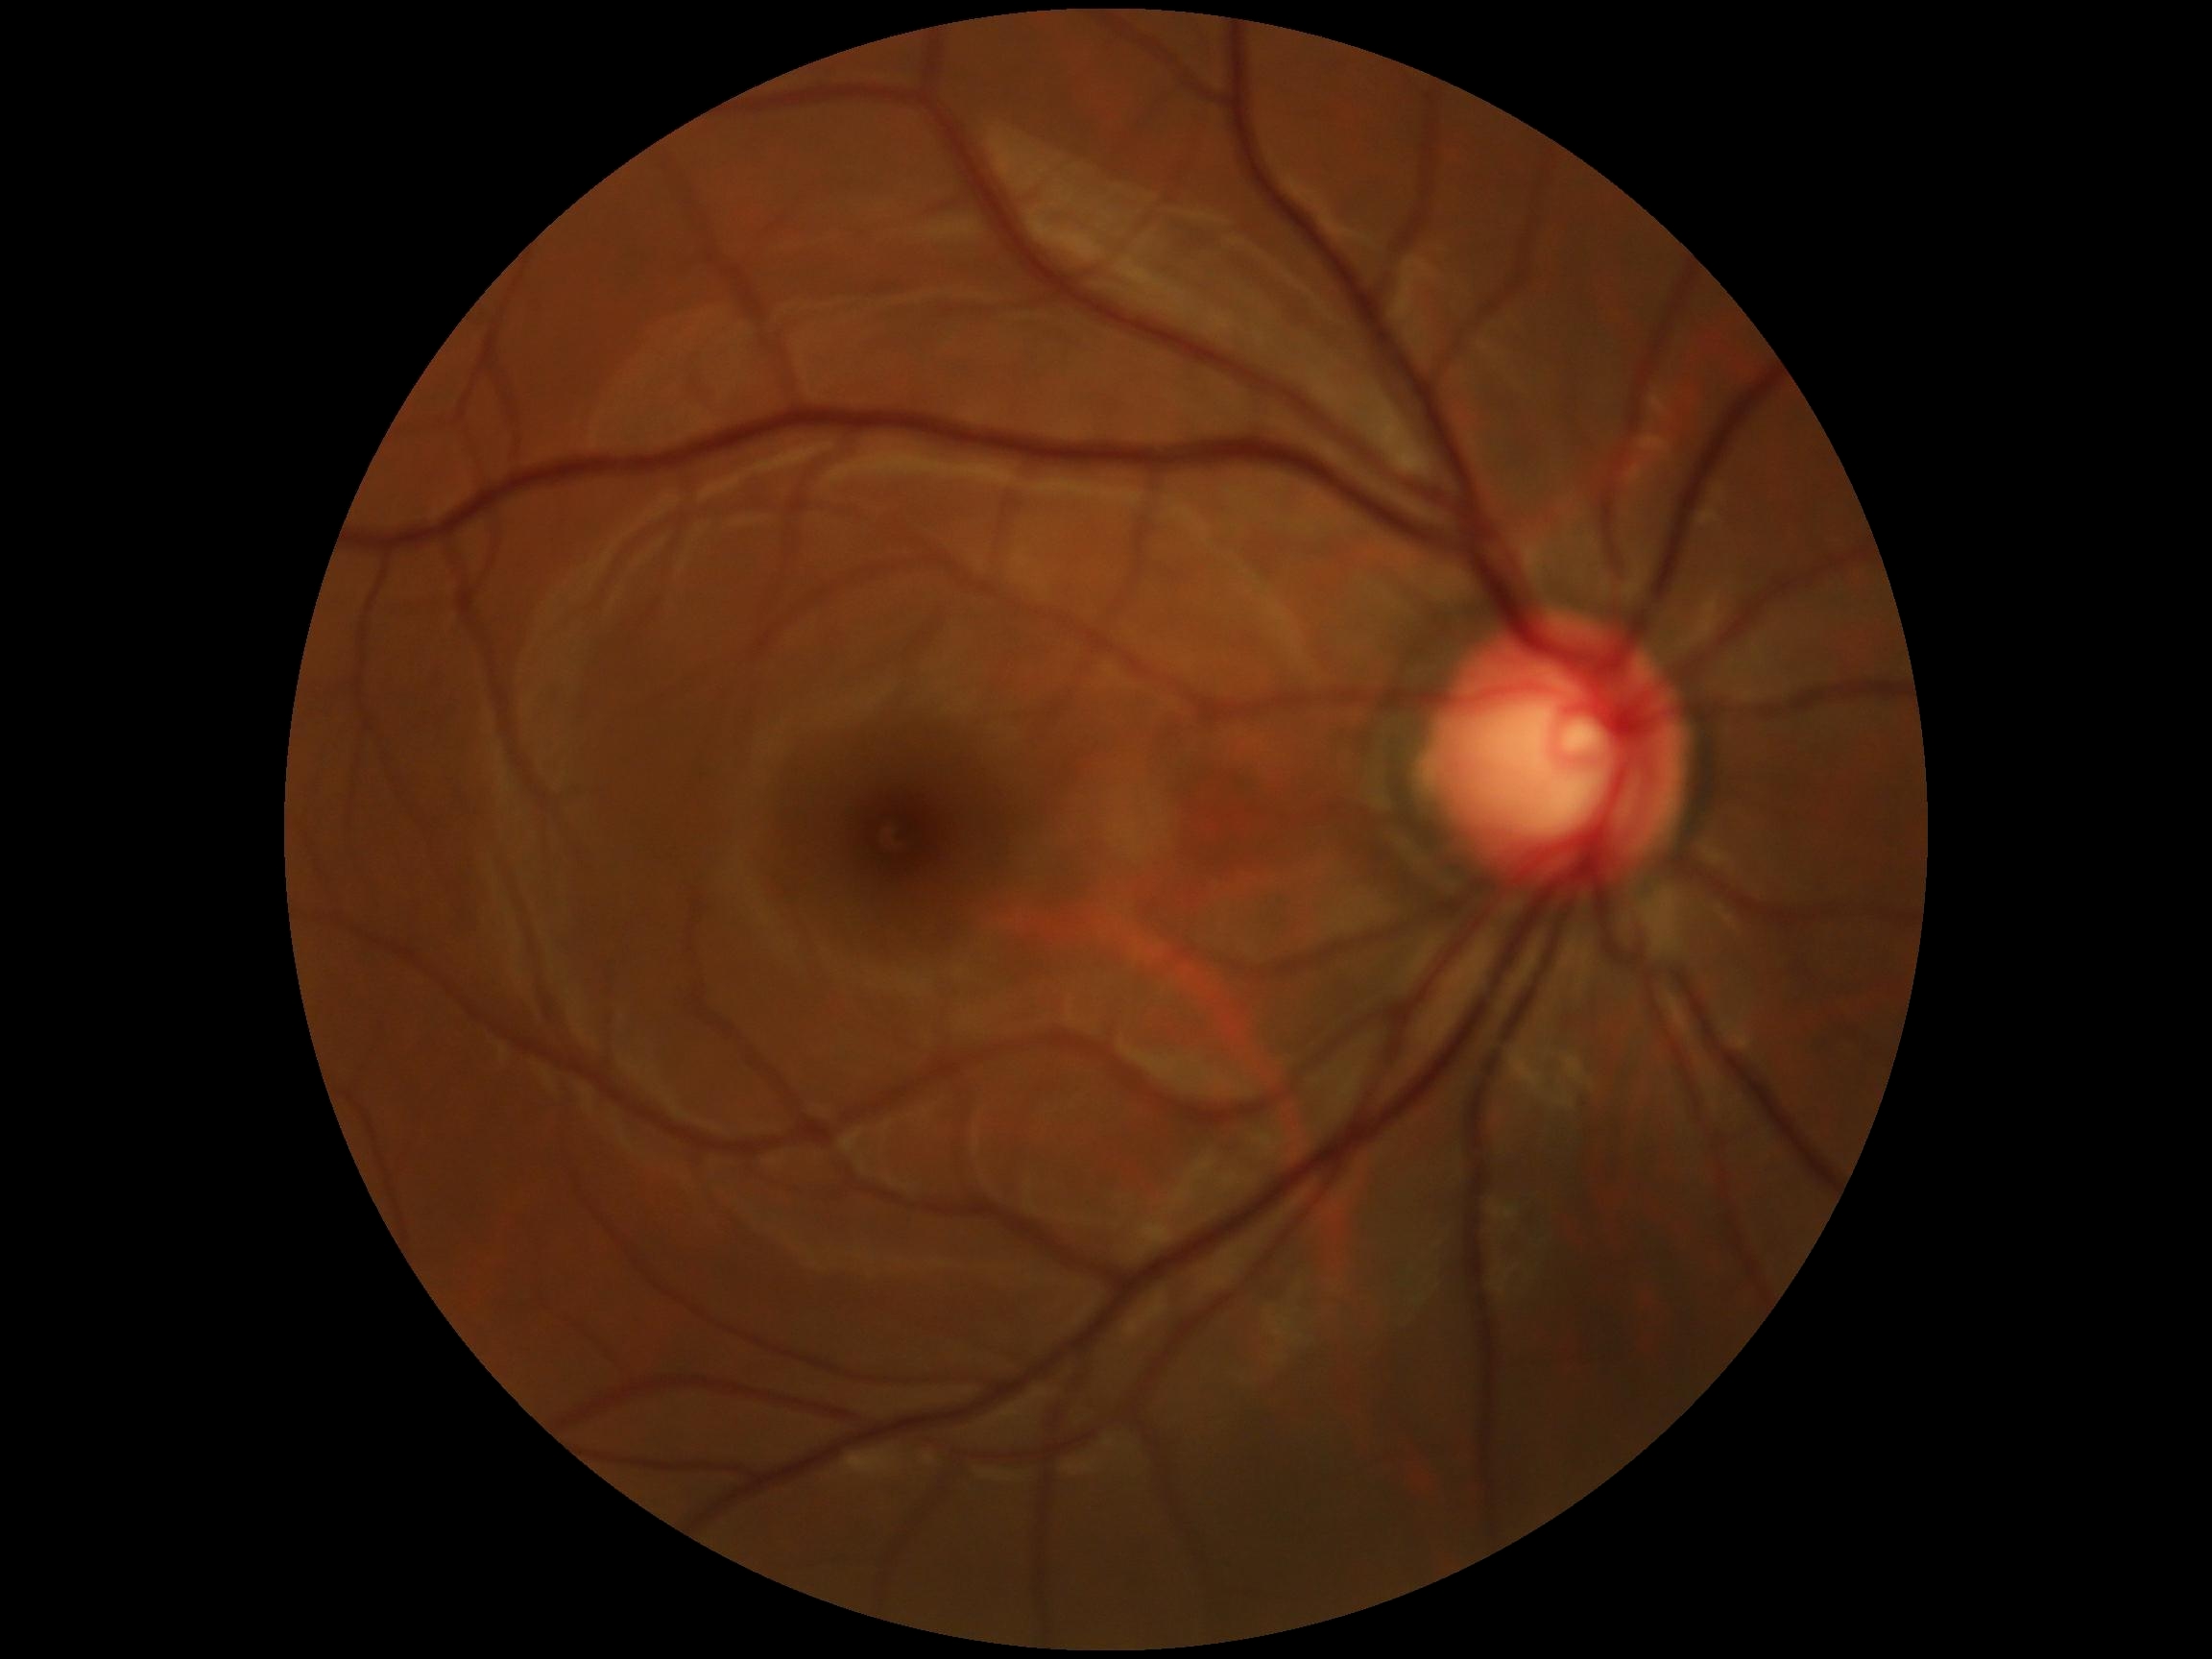

diabetic retinopathy severity: no apparent retinopathy (grade 0)